848 x 848 pixels.
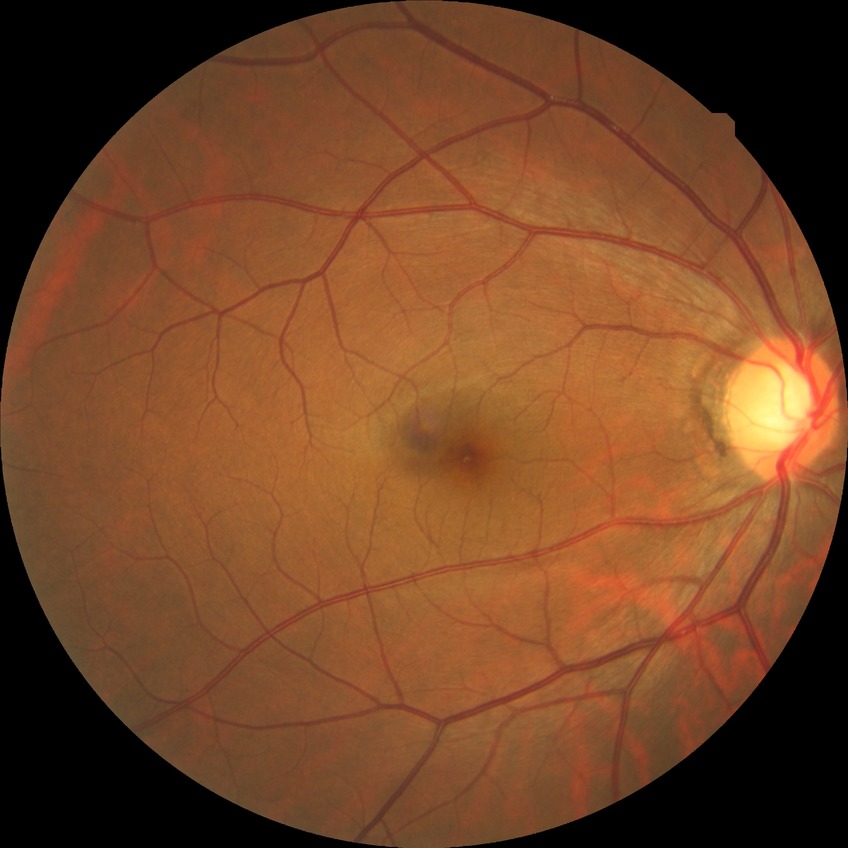 – diabetic retinopathy stage: no diabetic retinopathy